Fundus image cropped to the optic disc, captured with pupil dilation:
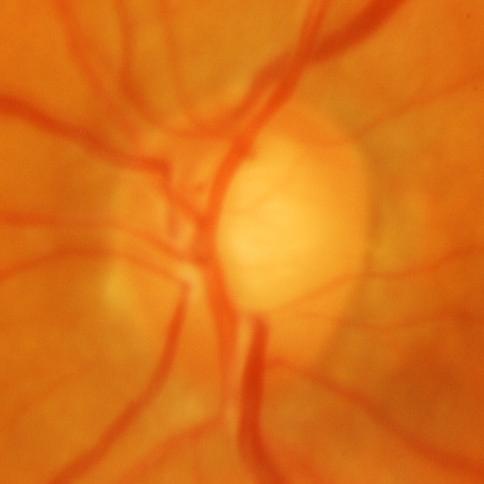

Glaucoma.